848x848; 45° field of view:
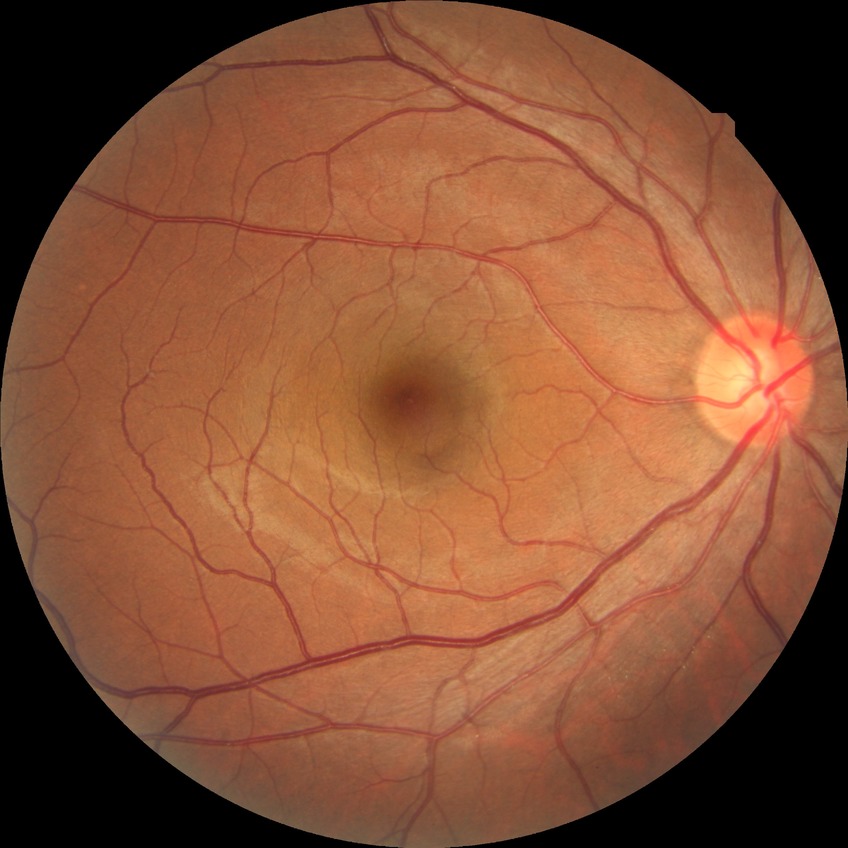

Diabetic retinopathy (DR) is no diabetic retinopathy (NDR).